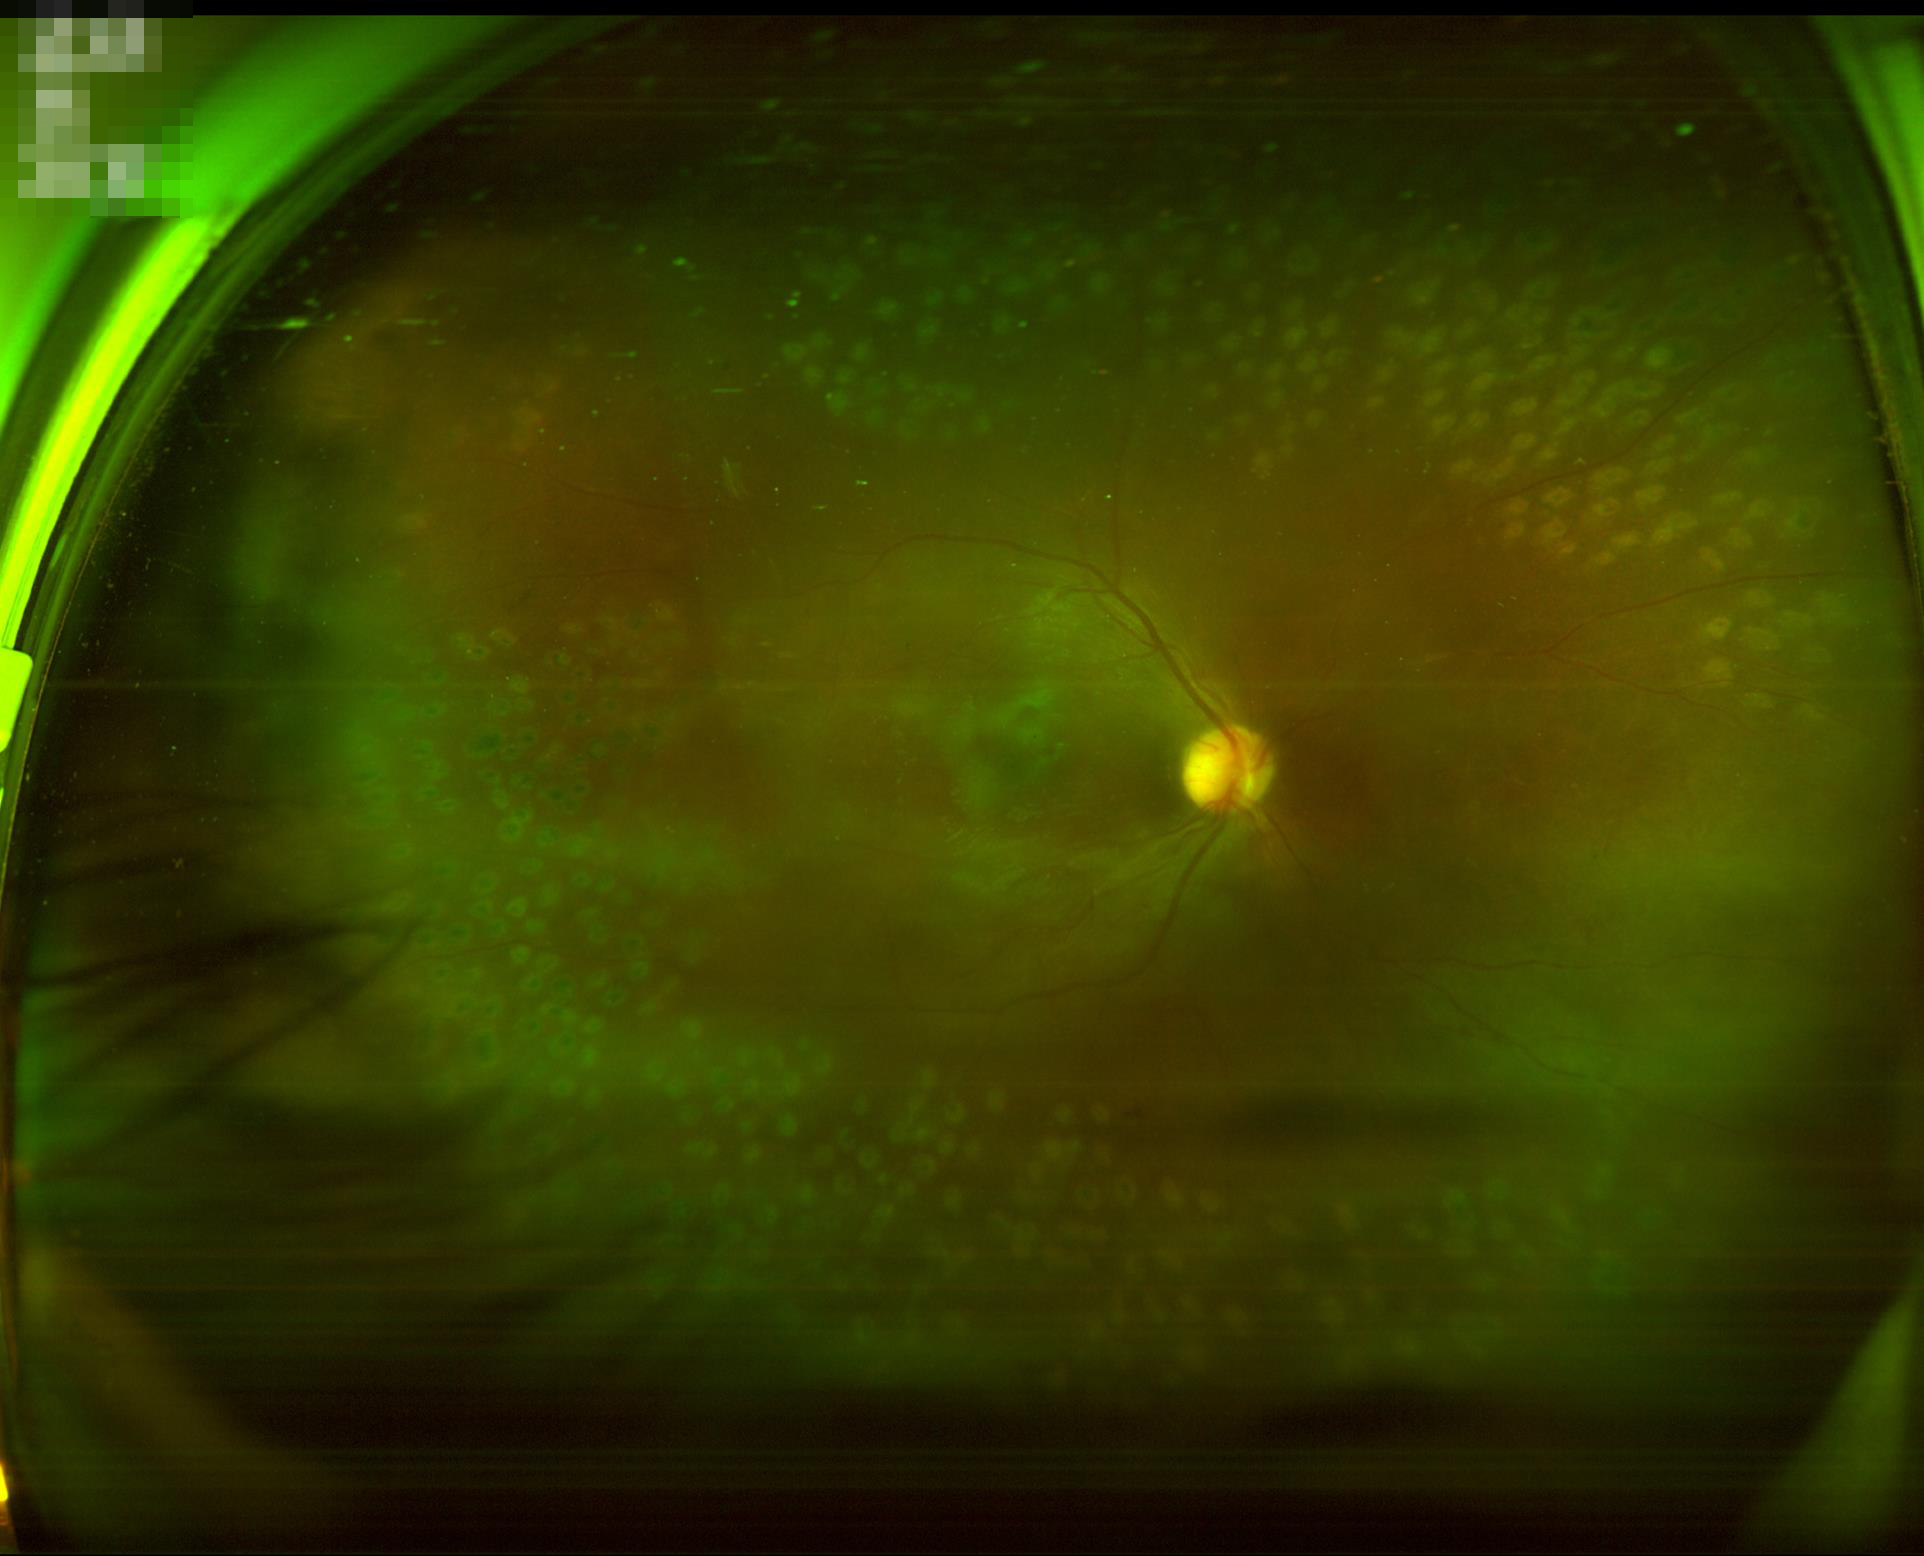
Vessels and details are readily distinguishable. Acceptable image quality. Out of focus; structures are indistinct. No over- or under-exposure.